1440 x 1080 pixels; infant wide-field fundus photograph: 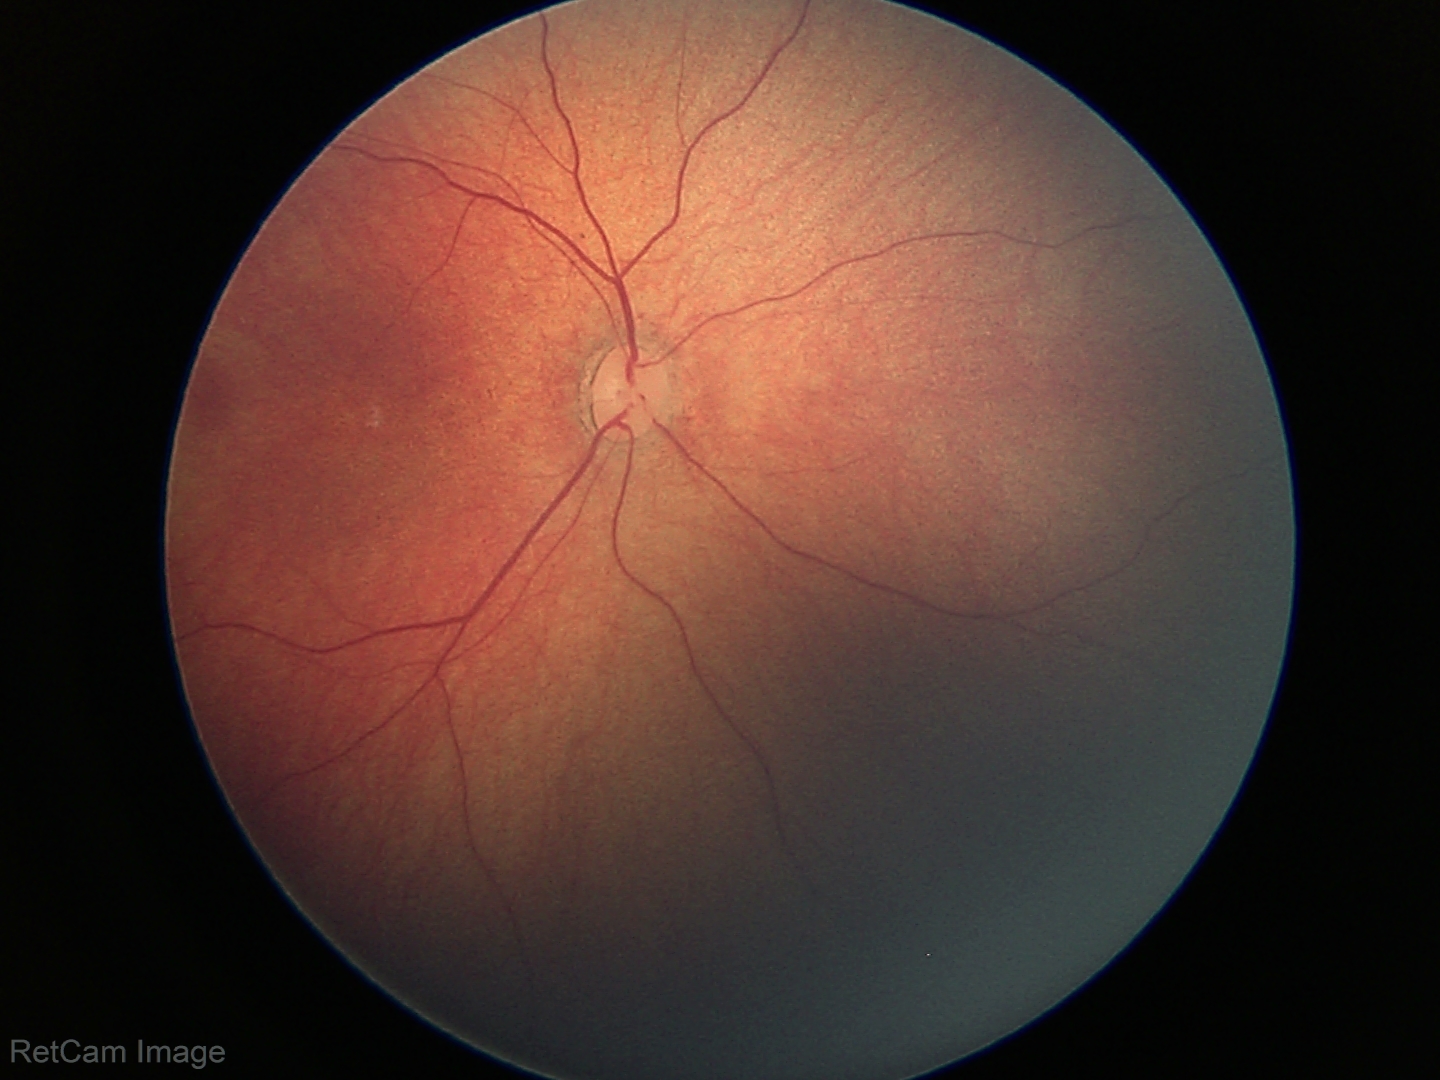
Screening examination with no abnormal retinal findings.